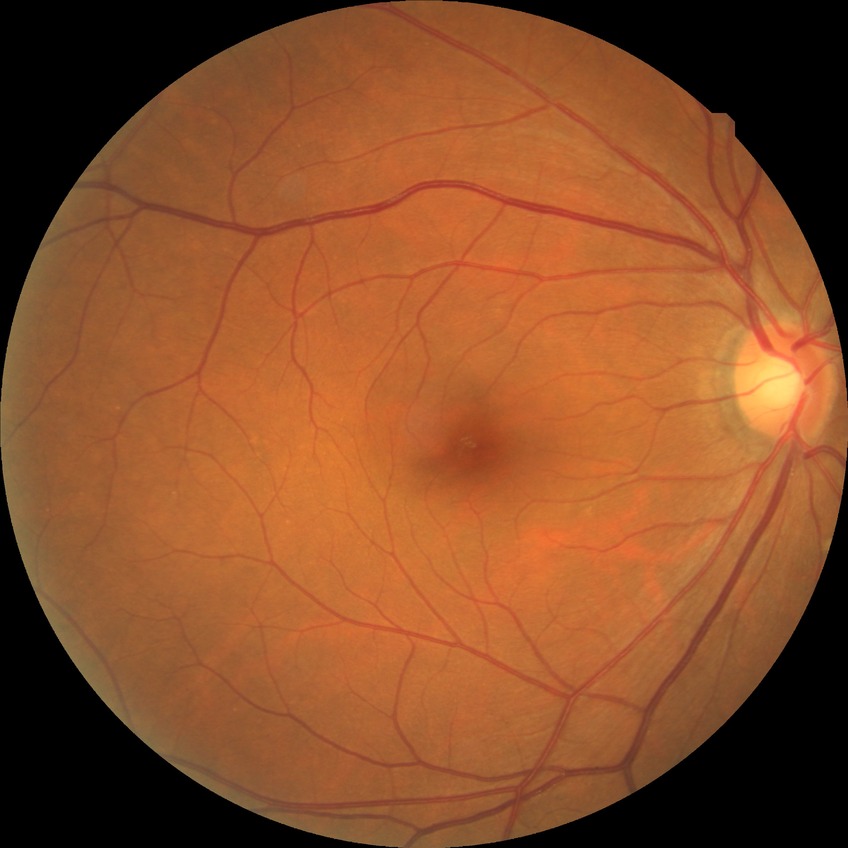
Davis DR grade is NDR.